Wide-field fundus photograph from neonatal ROP screening
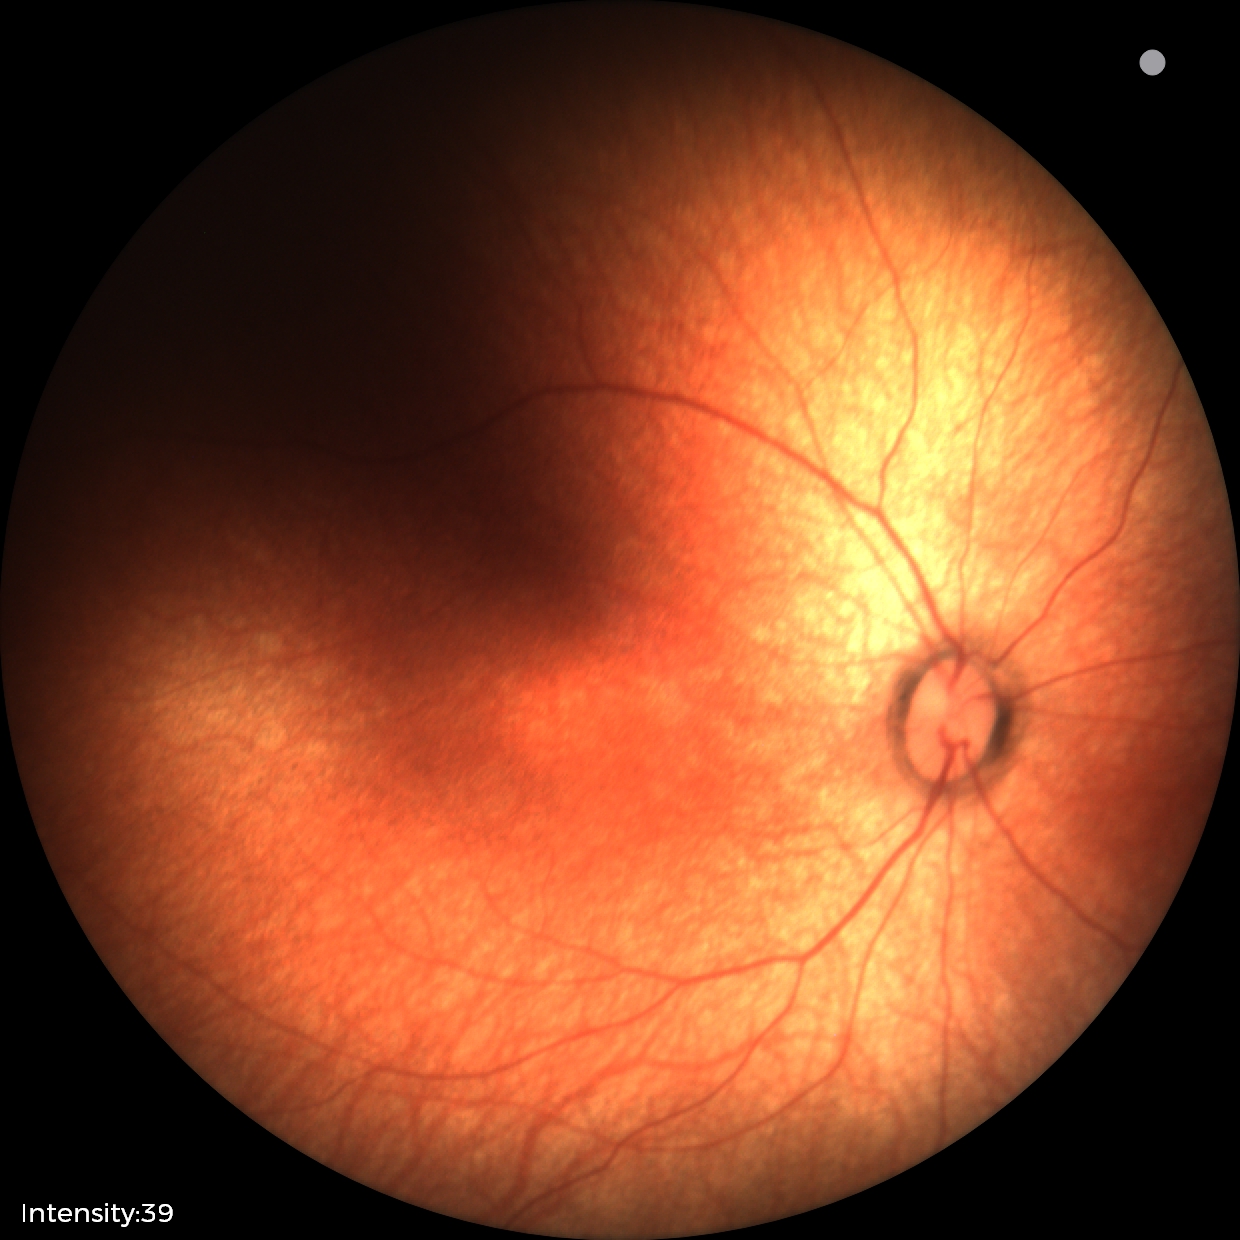 Physiological retinal appearance for postconceptual age.